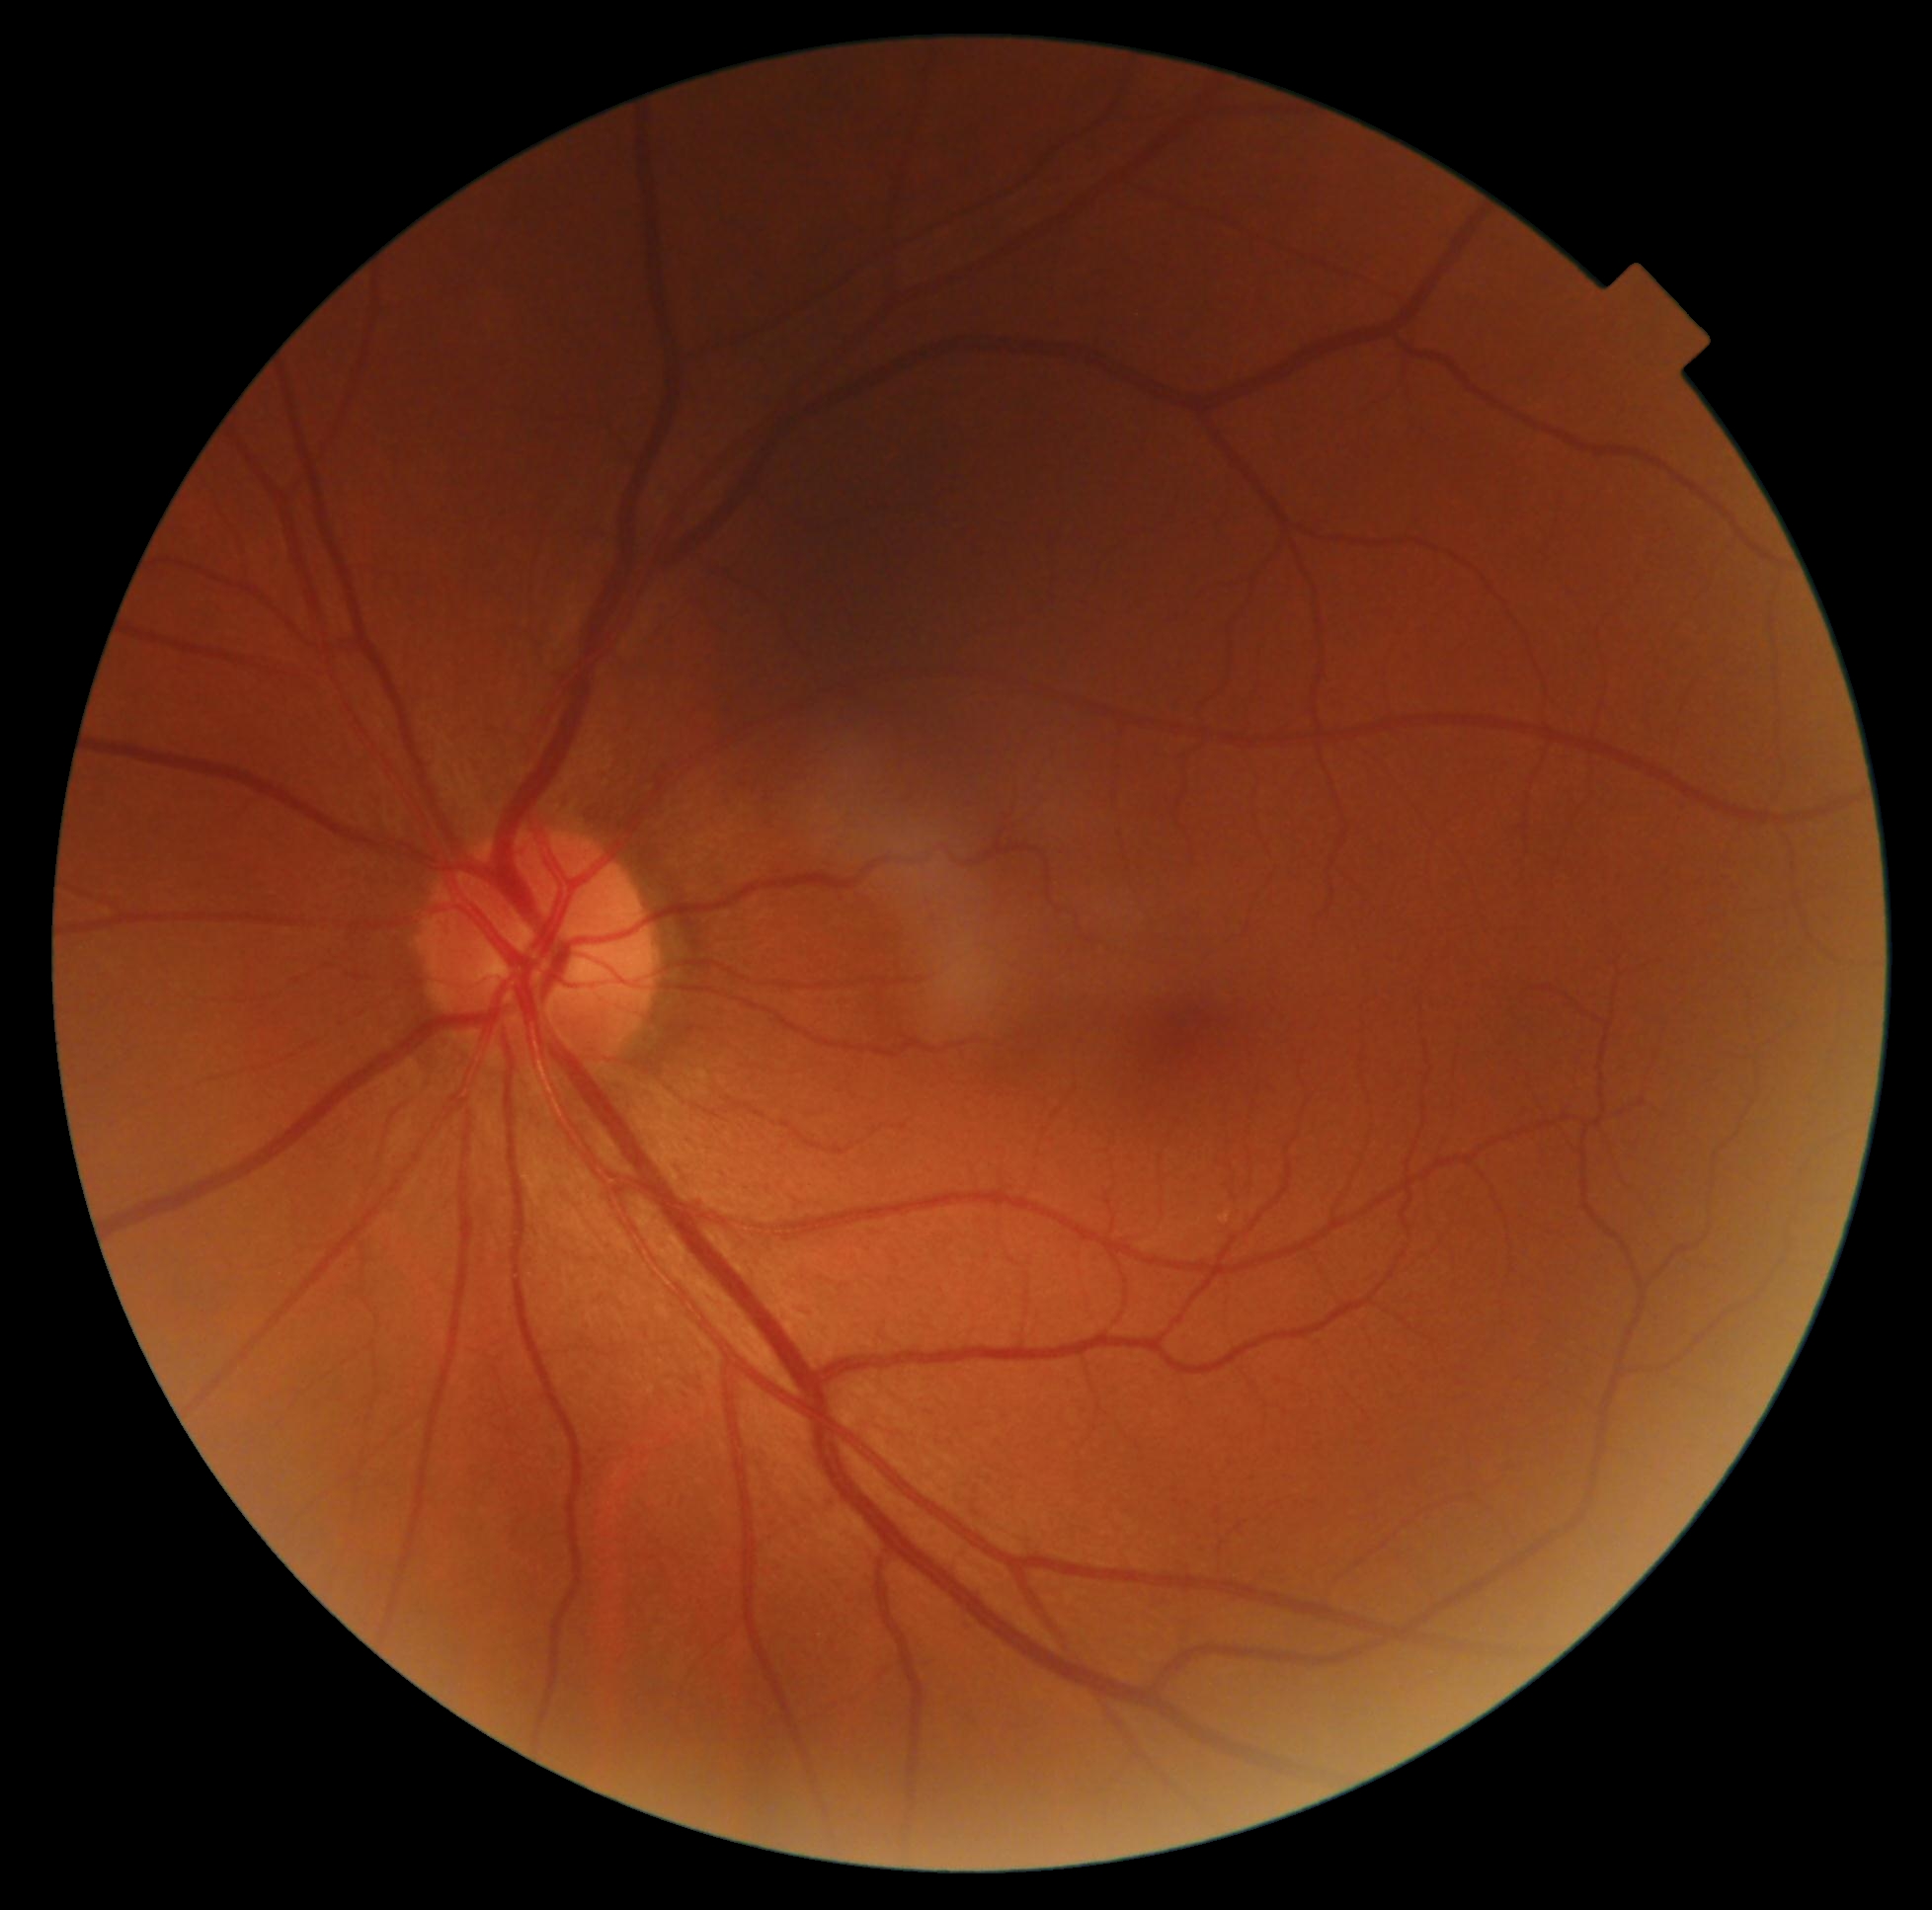

DR severity: grade 0 (no apparent retinopathy).